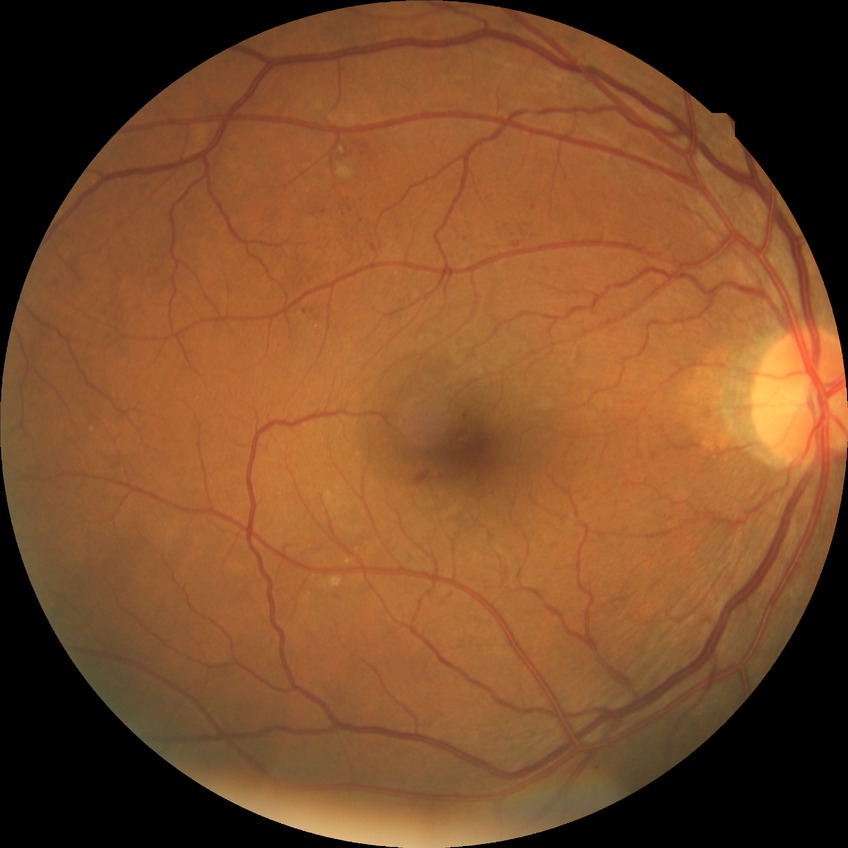
diabetic retinopathy (DR)@SDR (simple diabetic retinopathy).